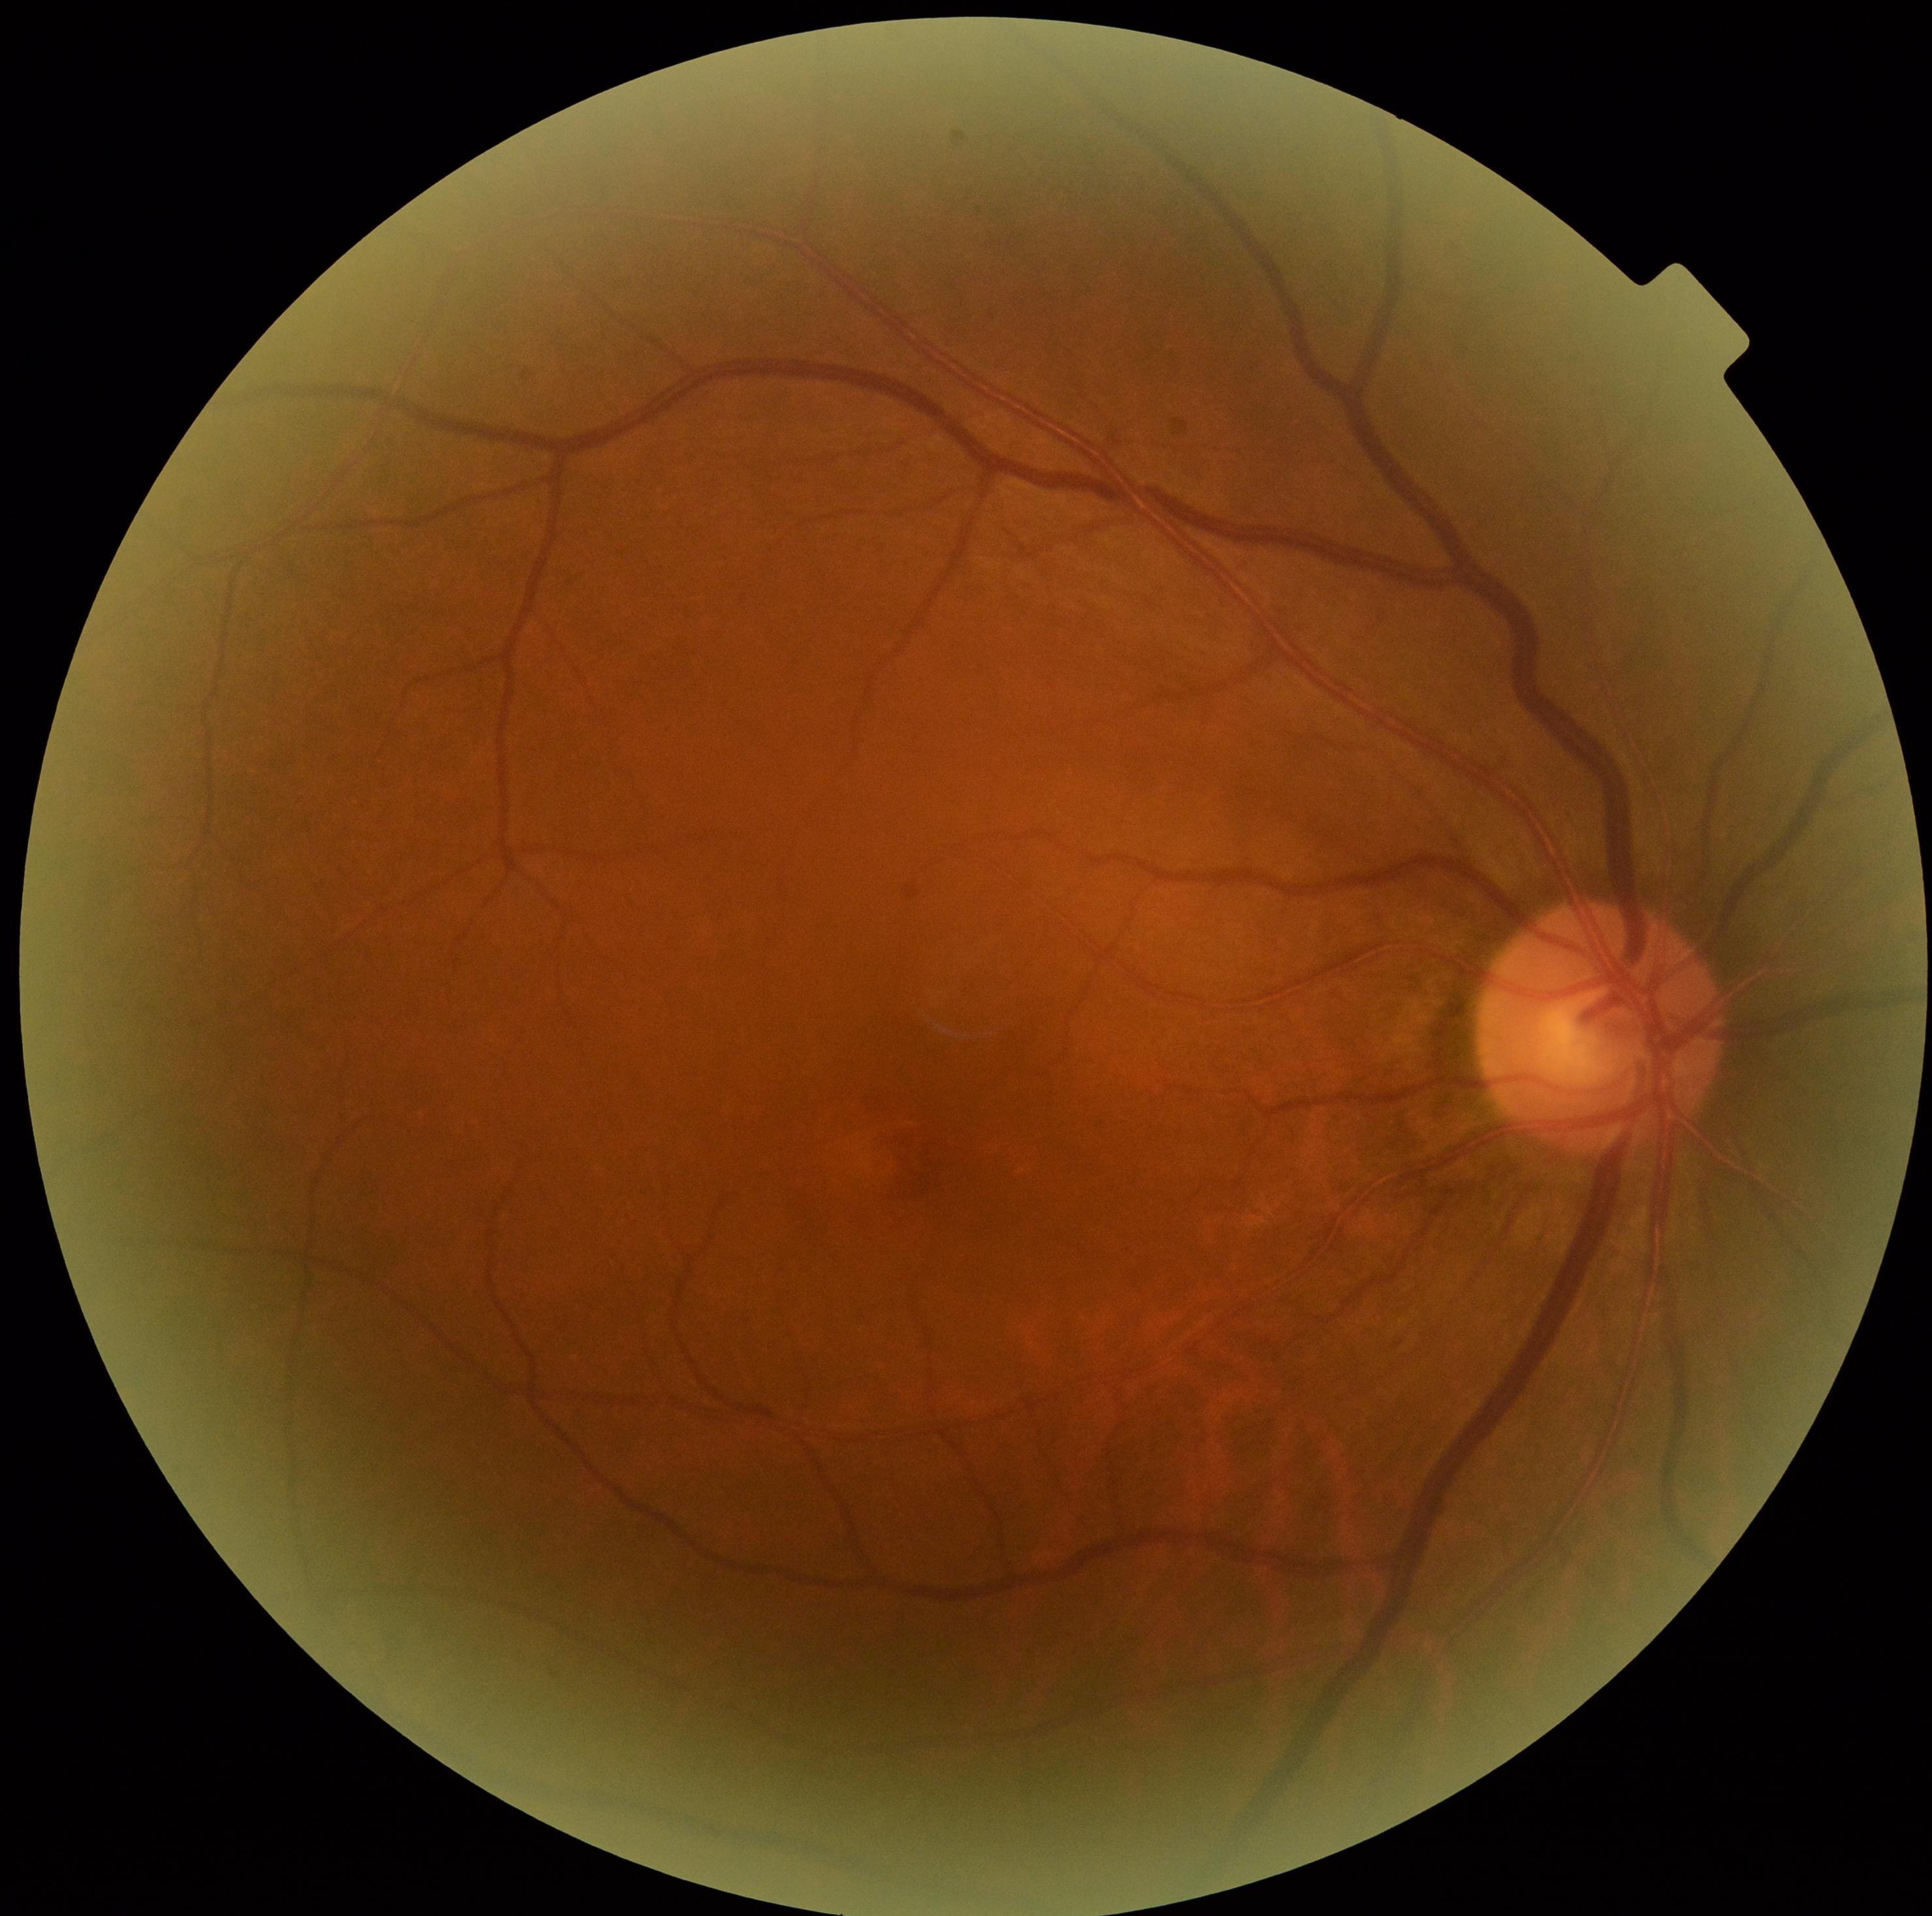
* diabetic retinopathy (DR) — 0